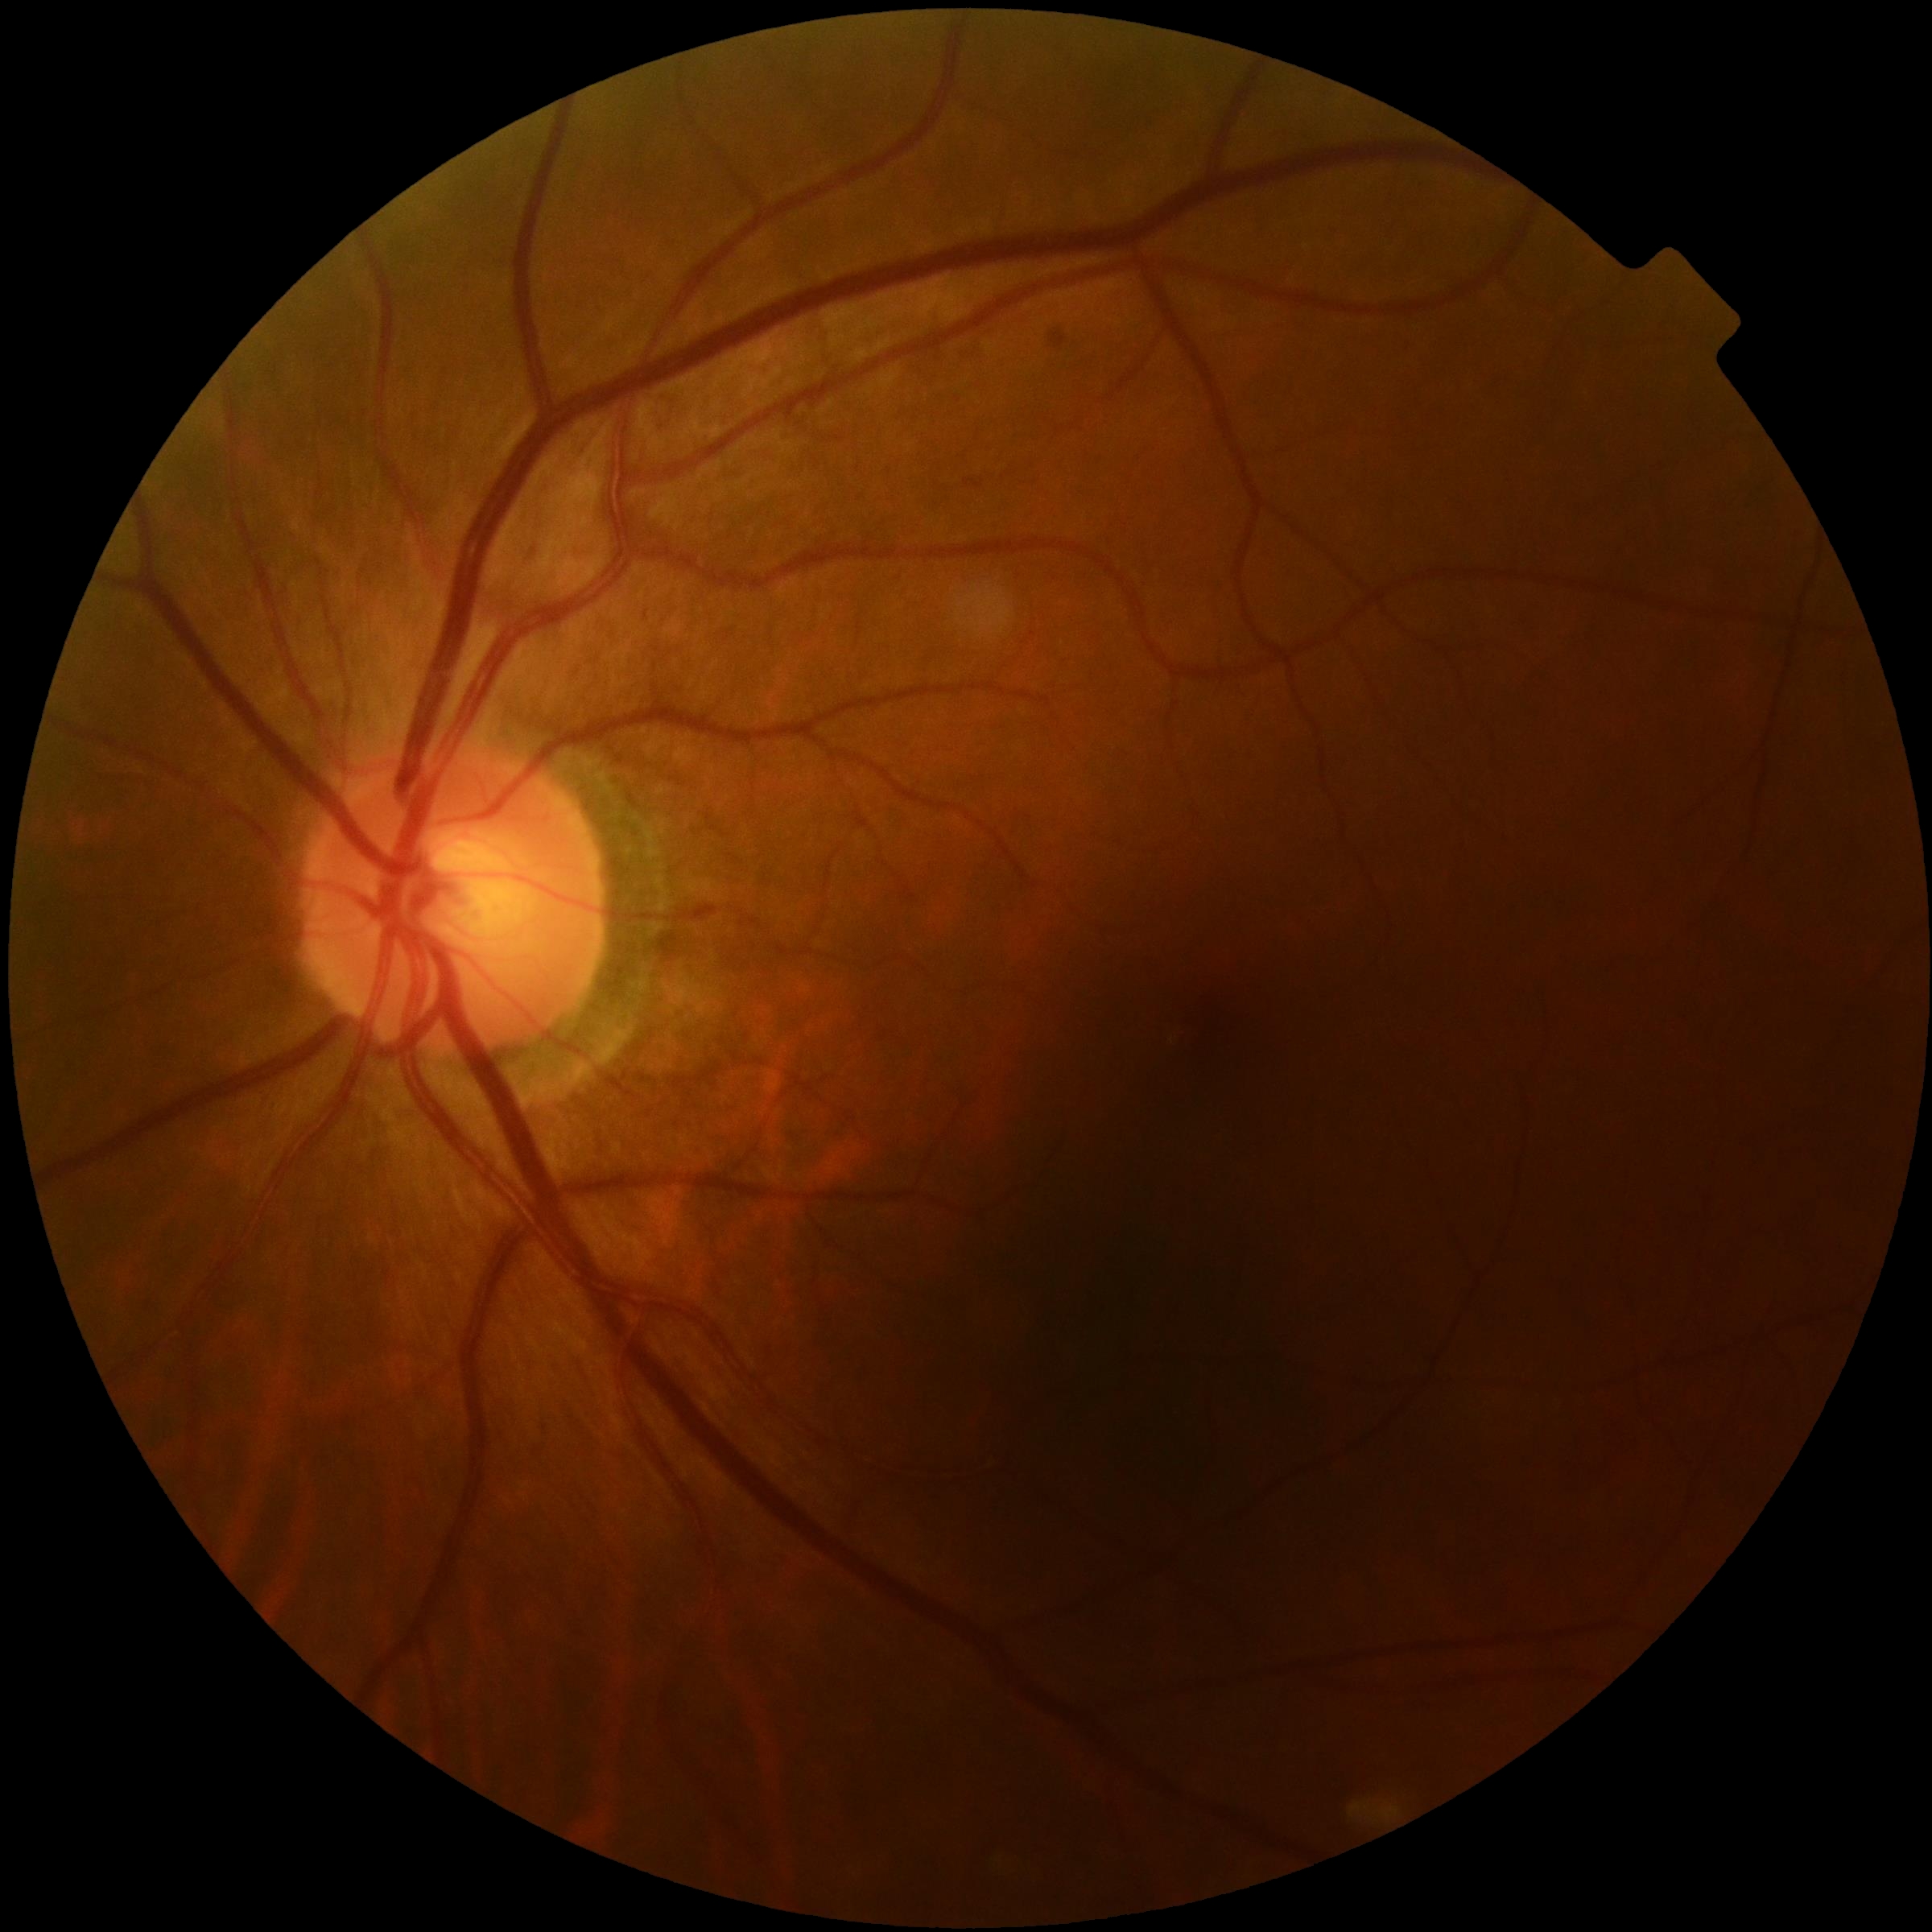

DR severity = no apparent diabetic retinopathy (grade 0).